Infant wide-field retinal image
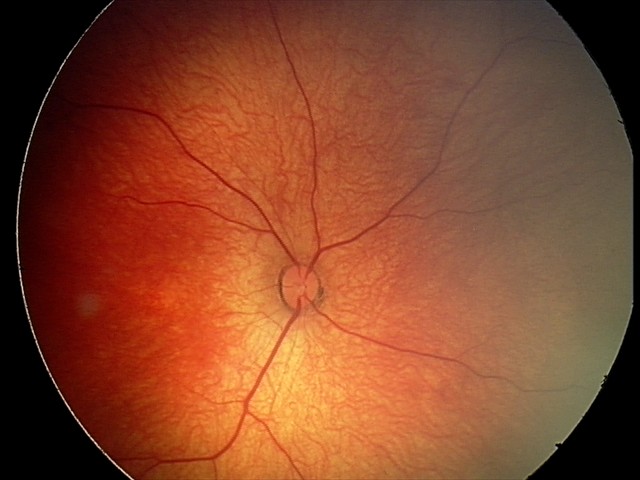
Diagnosis from this screening exam: retinal hemorrhages.